Modified Davis grading
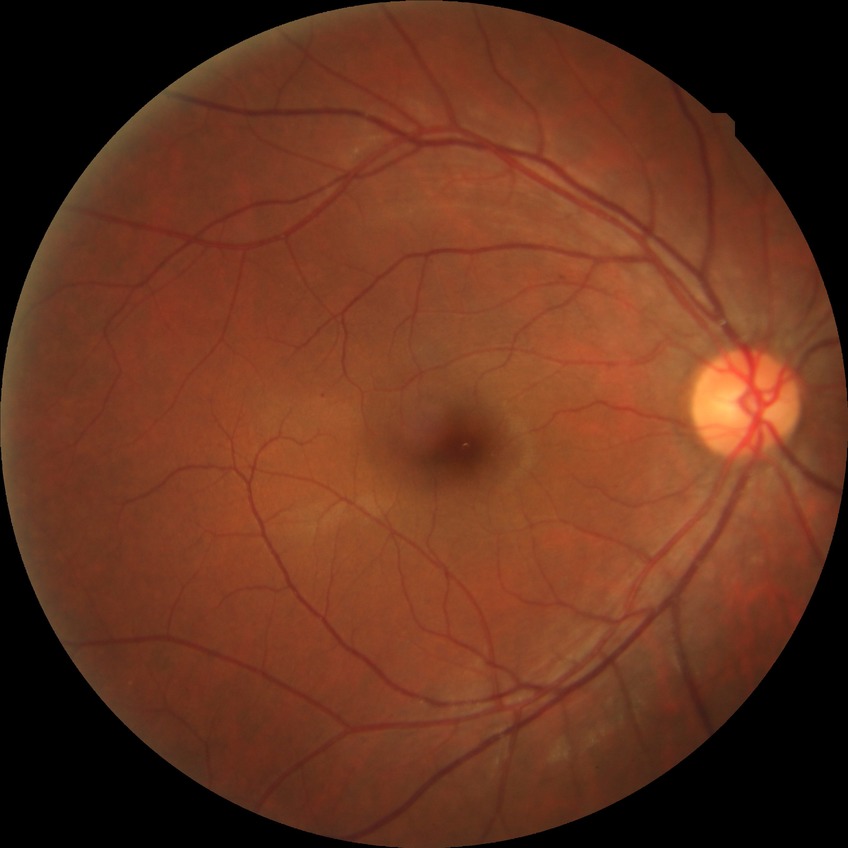 Davis DR grade is SDR.